Wide-field contact fundus photograph of an infant:
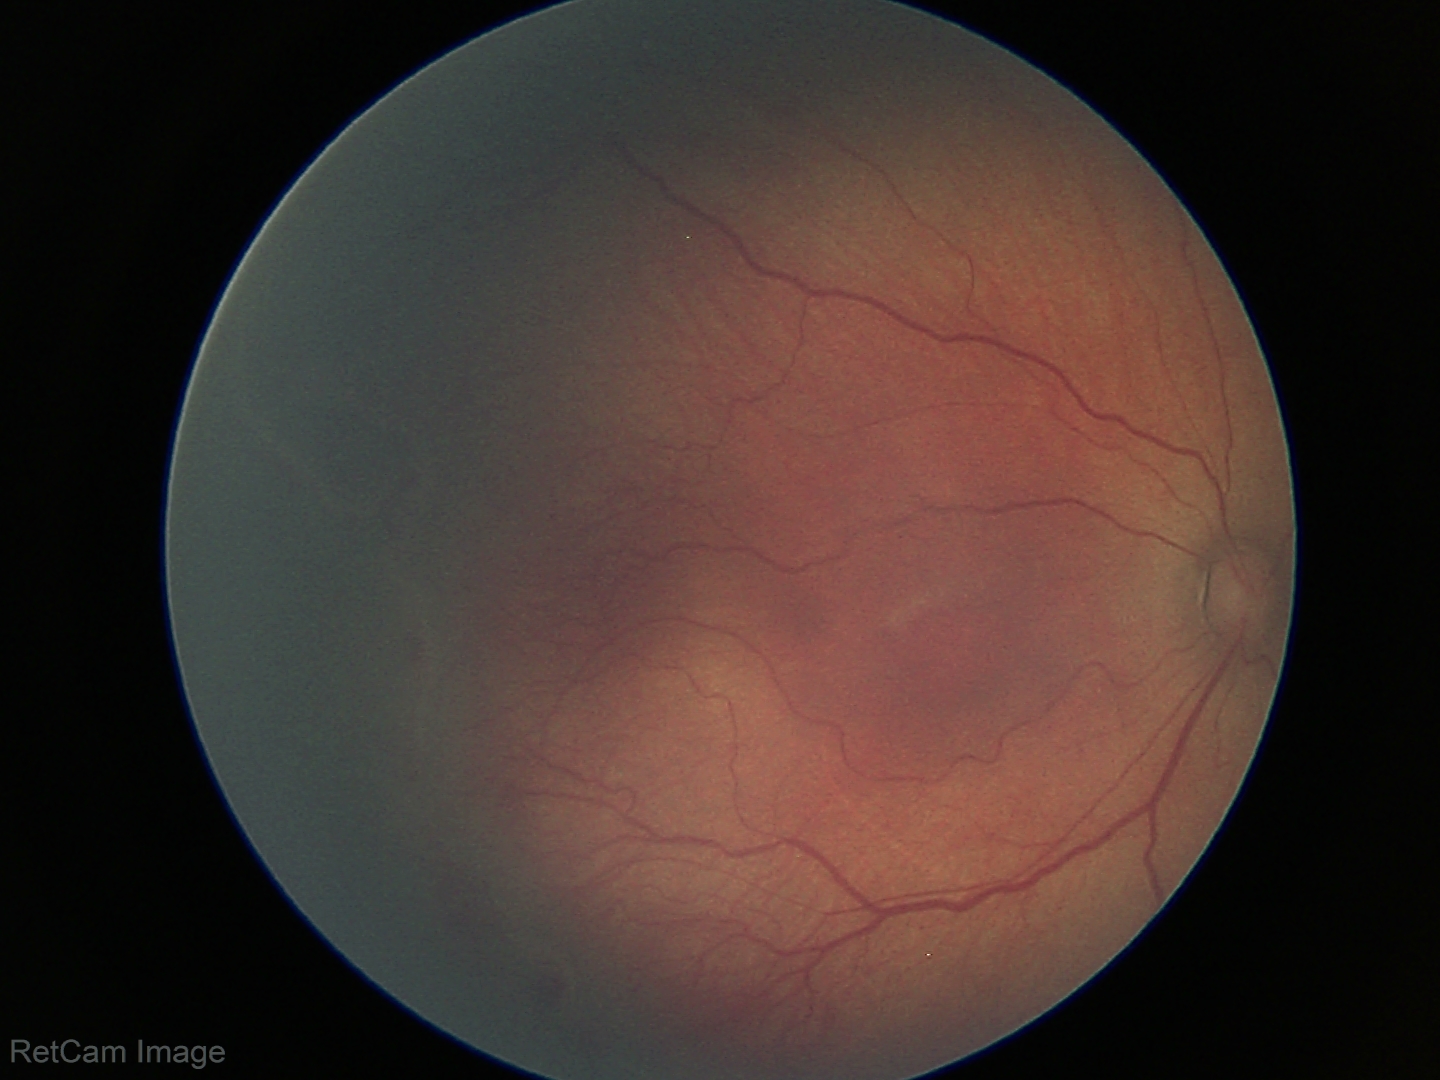

Diagnosis: retinopathy of prematurity stage 2.